Pachymetry 496 µm; disc-centered field; age 79; 30° FOV; 2212x1661px; man patient; intraocular pressure: 17.7 mmHg
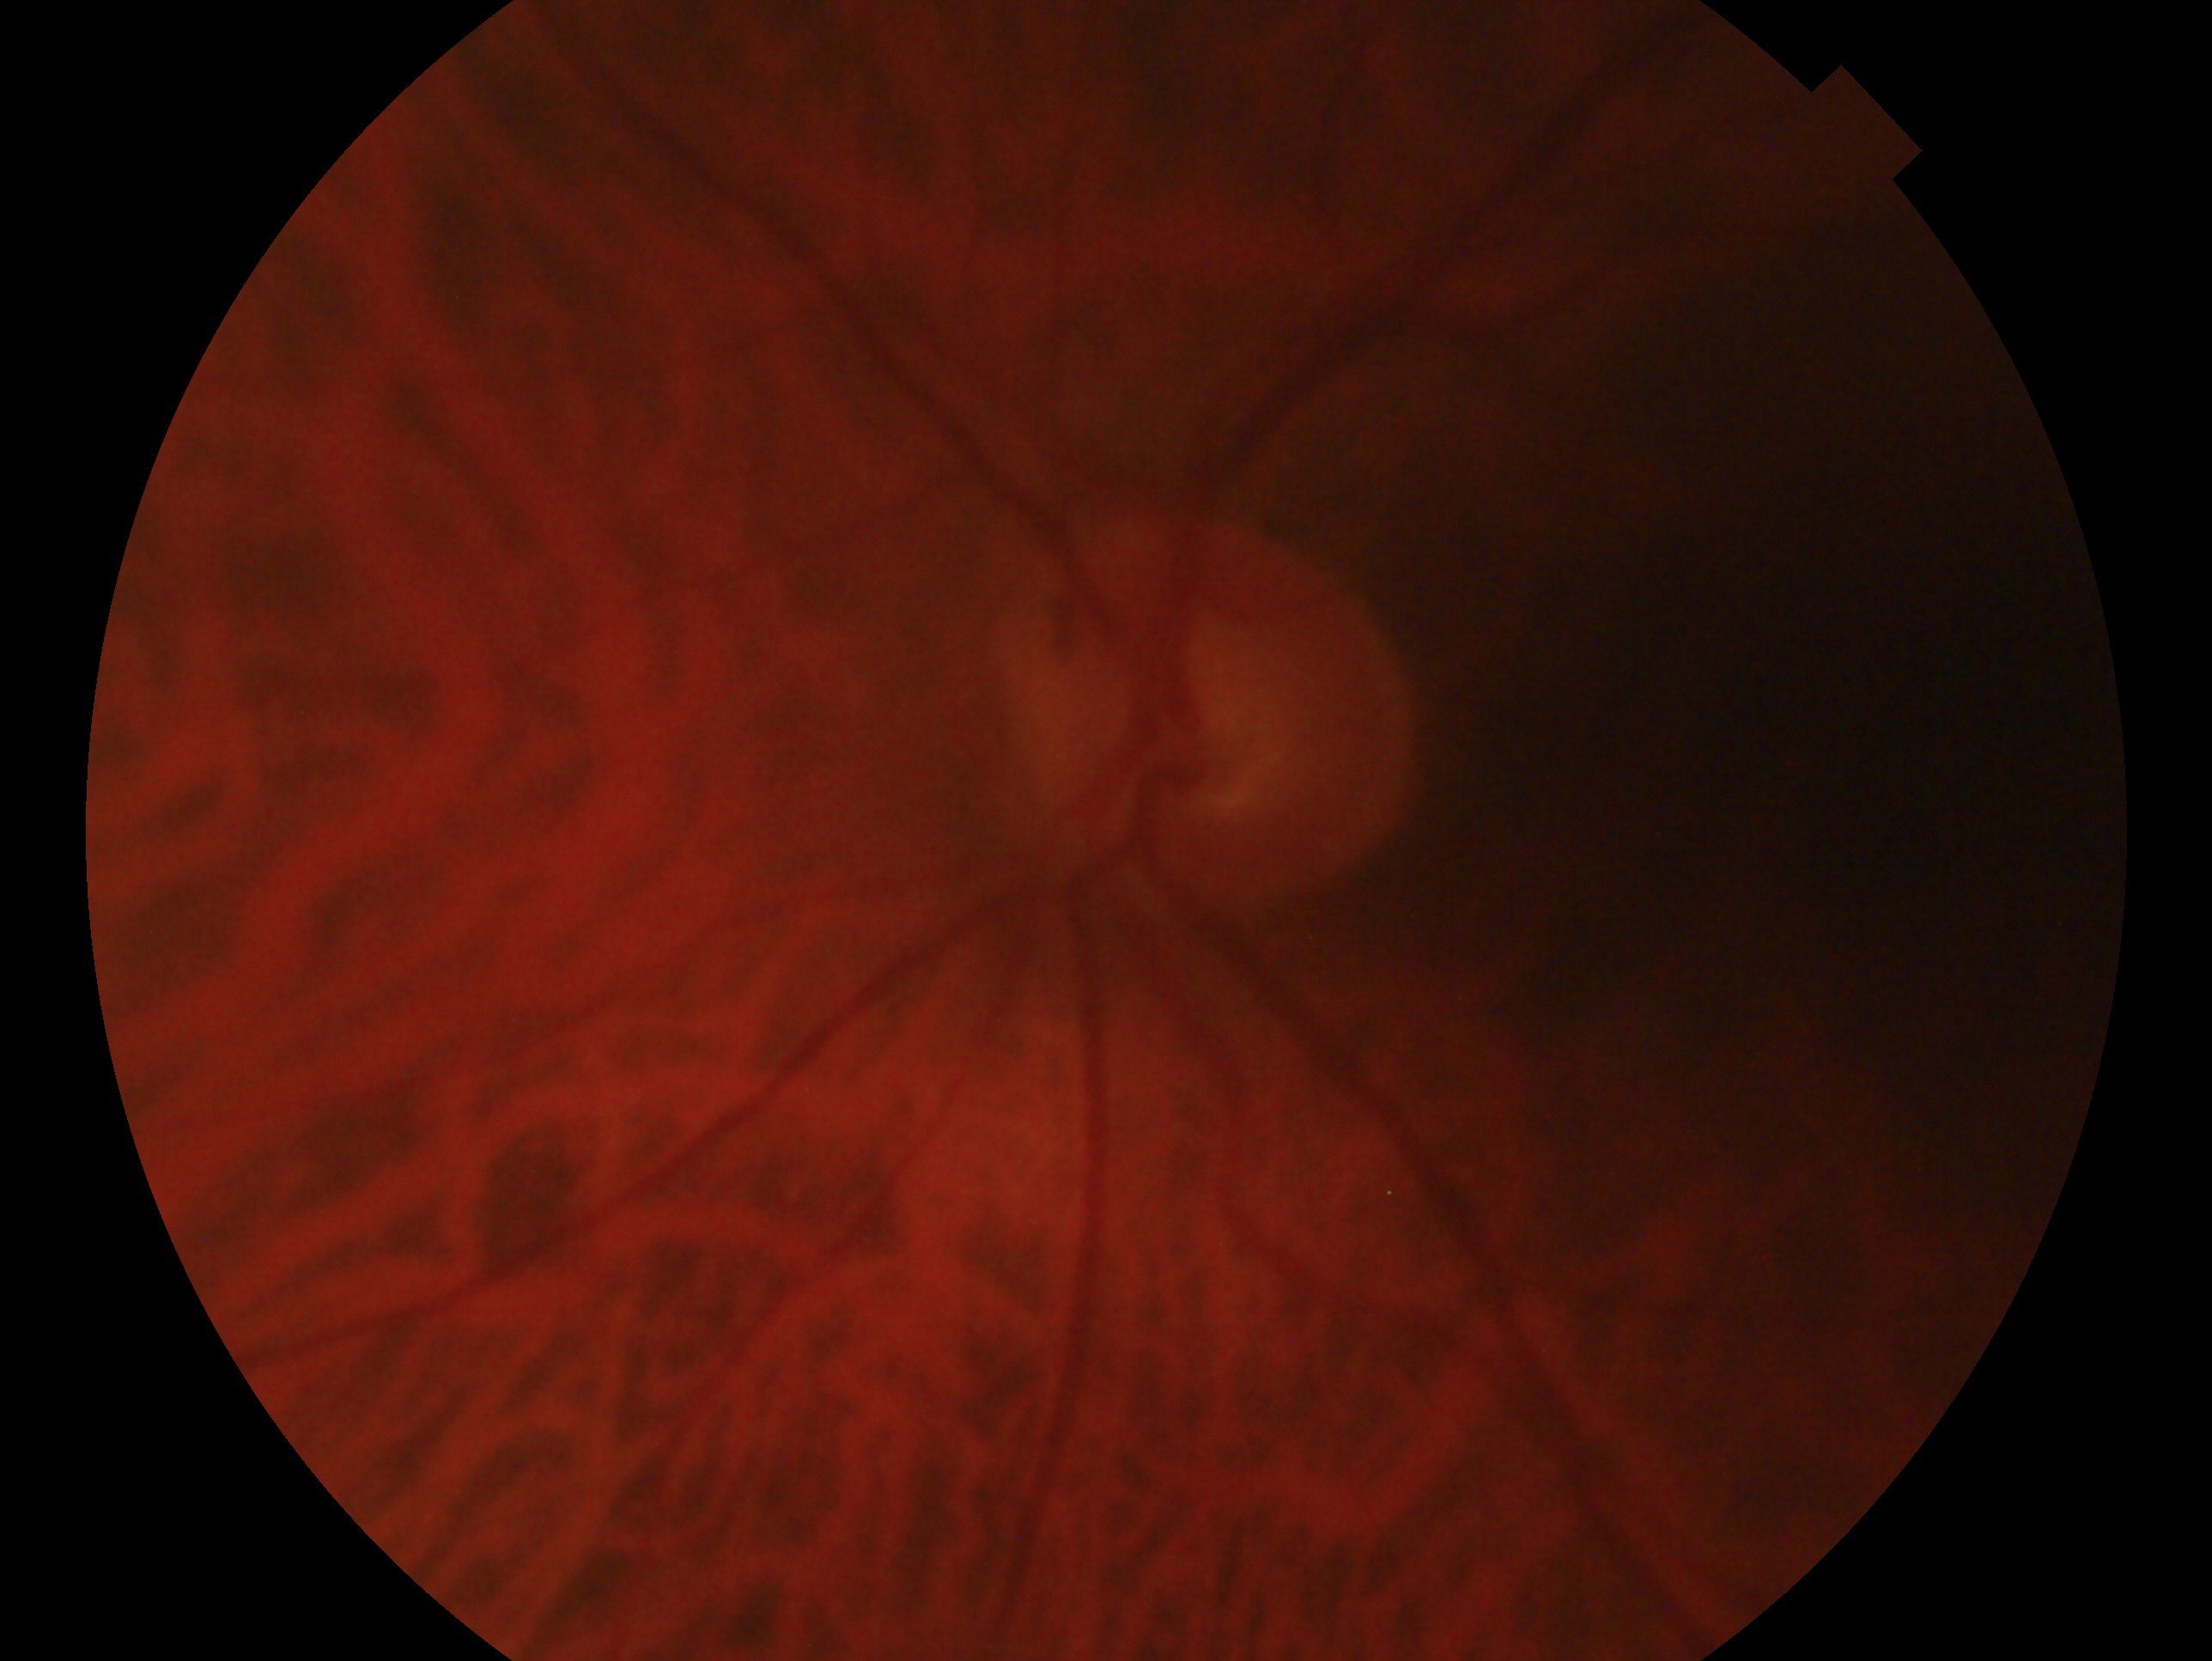 Glaucoma status: no glaucoma — no clinical evidence of glaucoma in this eye.
Imaged eye: left.